No pharmacologic dilation; 848x848 — 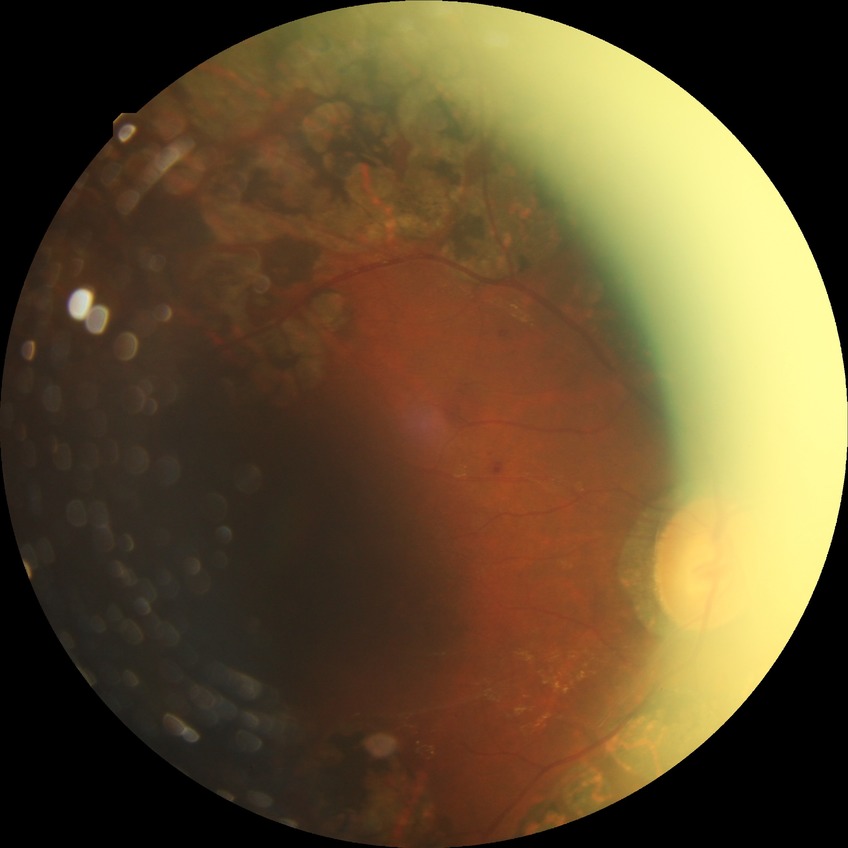
diabetic retinopathy severity = proliferative diabetic retinopathy.